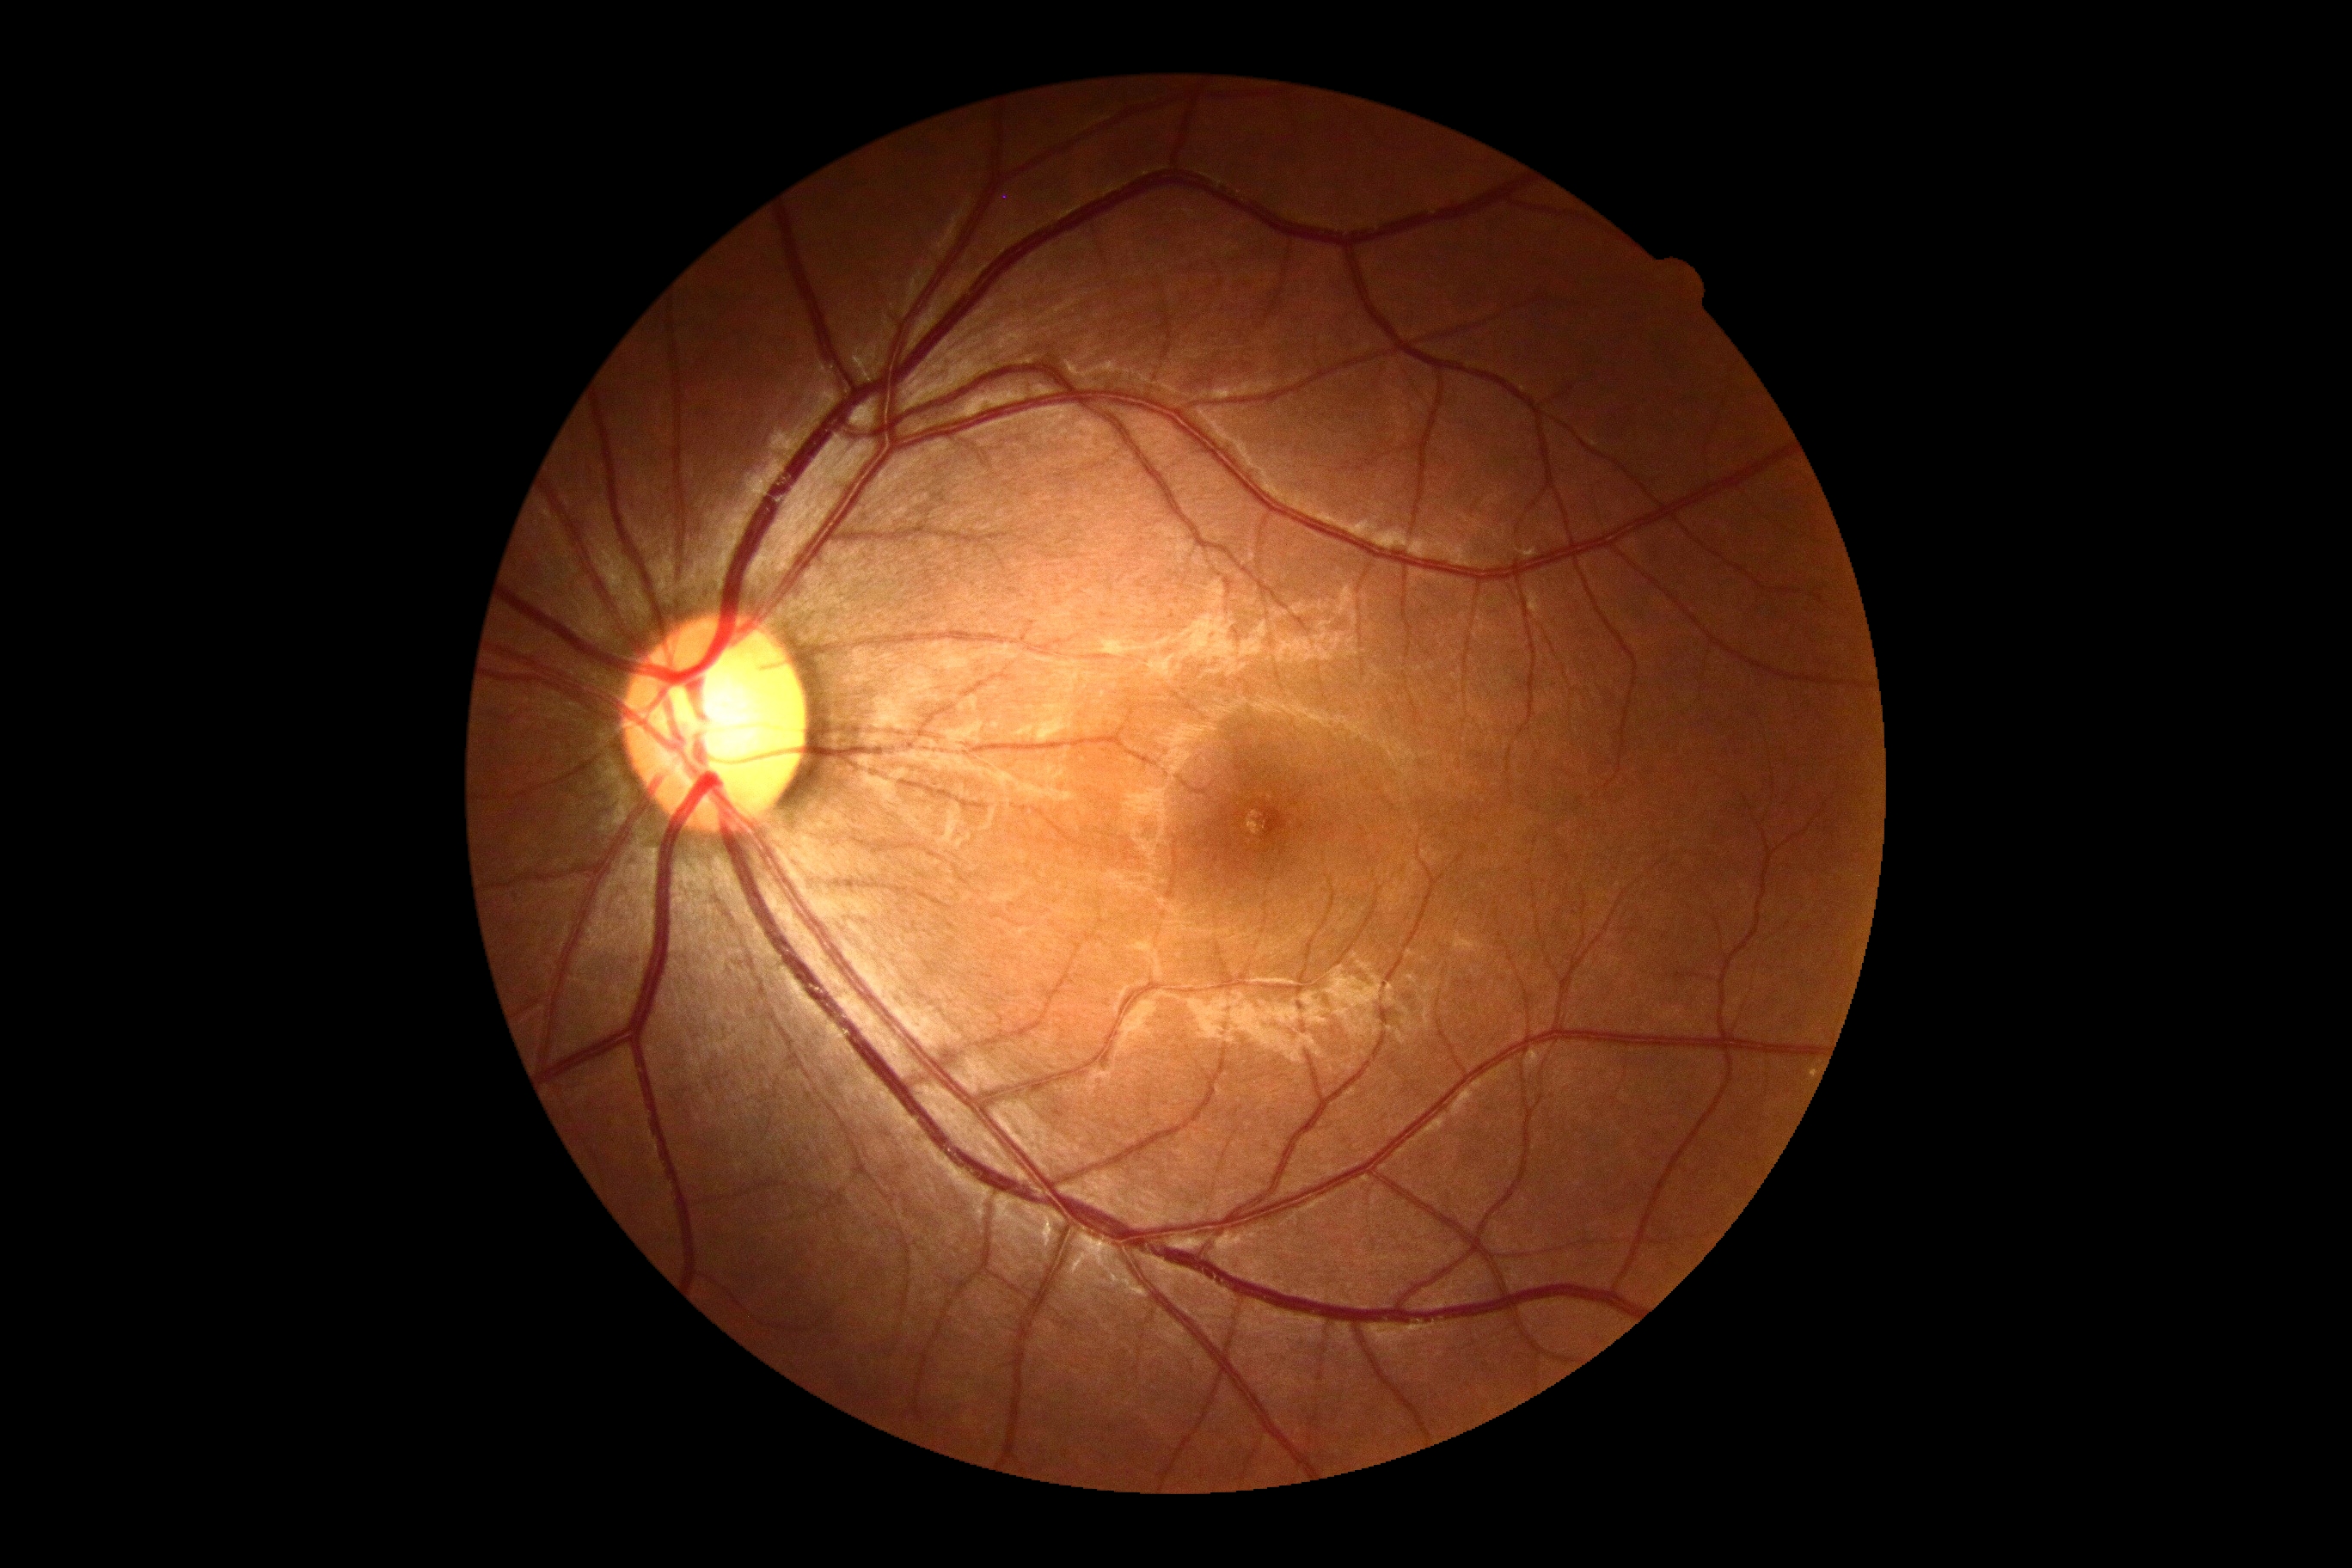 DR is grade 0.